Camera: Topcon TRC-50DX, dilated-pupil acquisition — 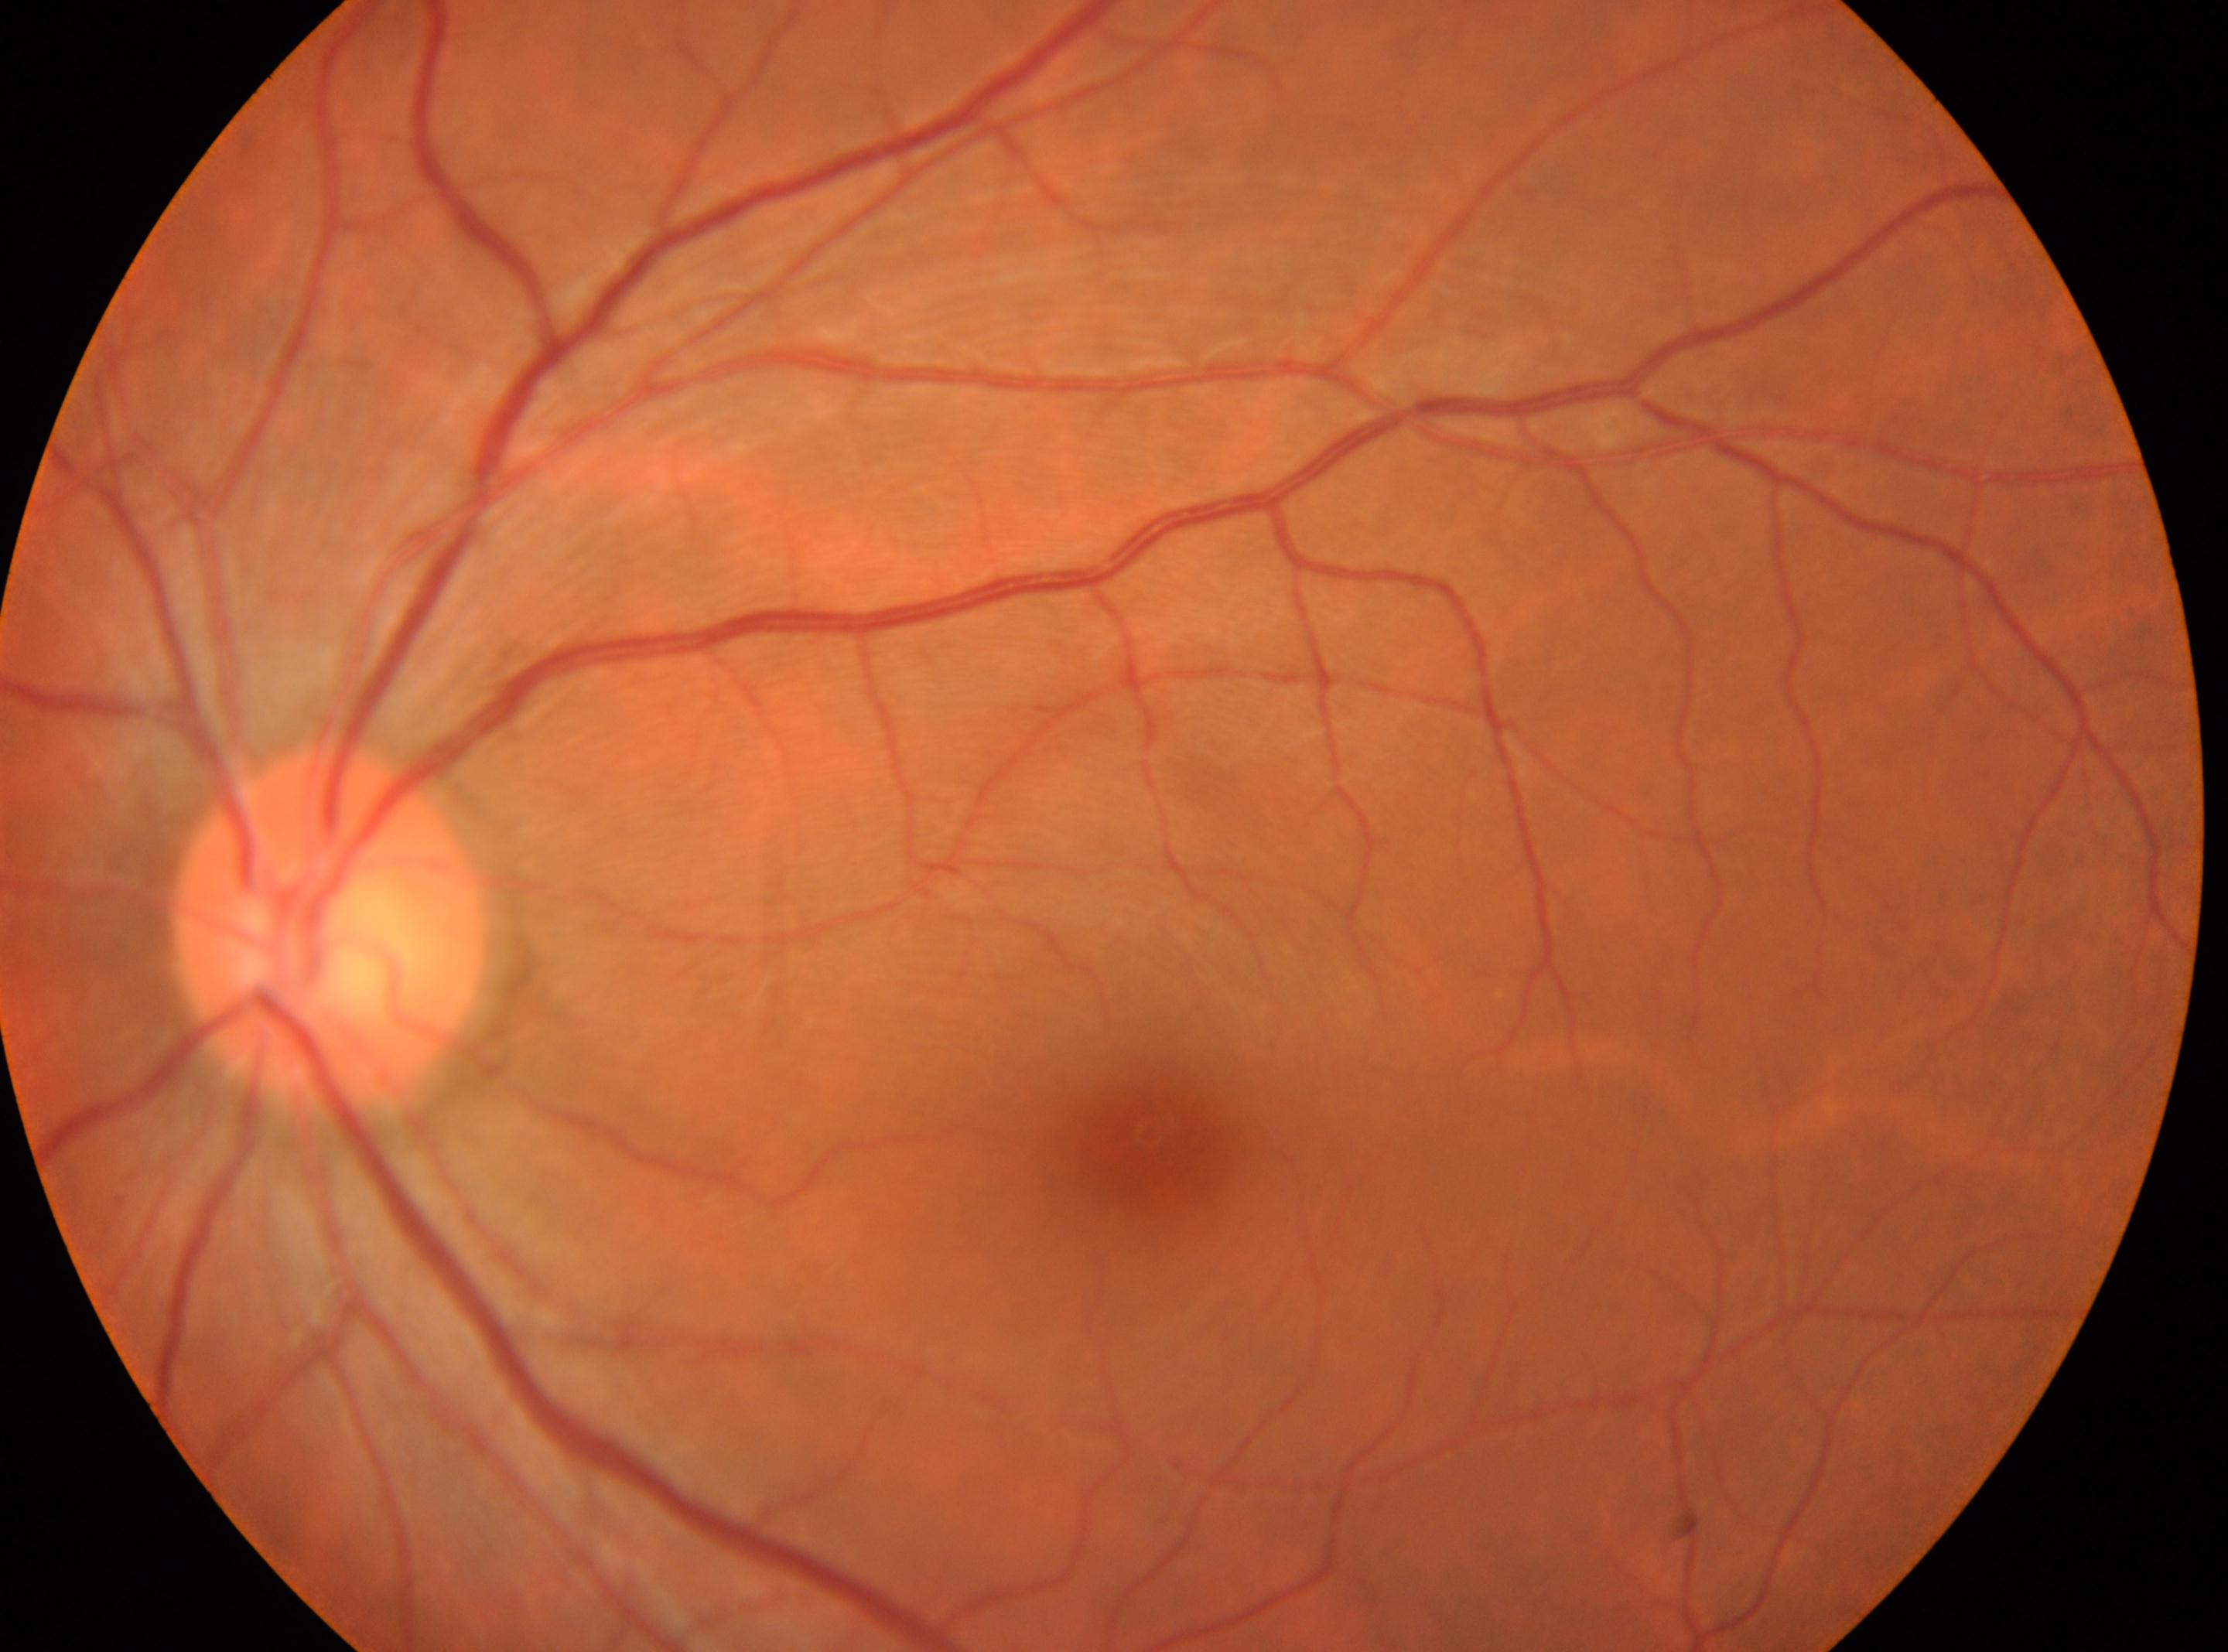
DR grade is 0 (no apparent retinopathy). The macular center is at (x: 1148, y: 1145). The image shows the oculus sinister. The optic nerve head is at (x: 330, y: 927).